Infant wide-field retinal image — 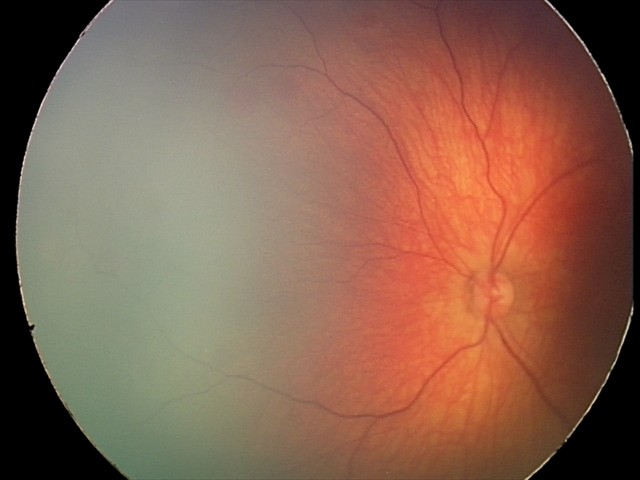

From an examination with diagnosis of retinal hemorrhages.